Pediatric wide-field fundus photograph · 640x480
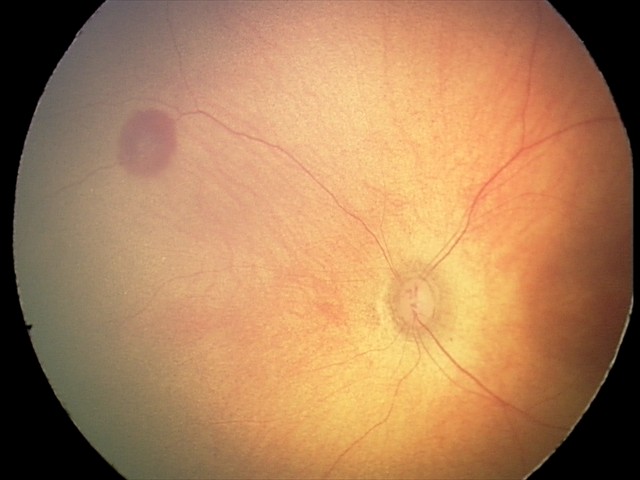 Impression = retinal hemorrhages.